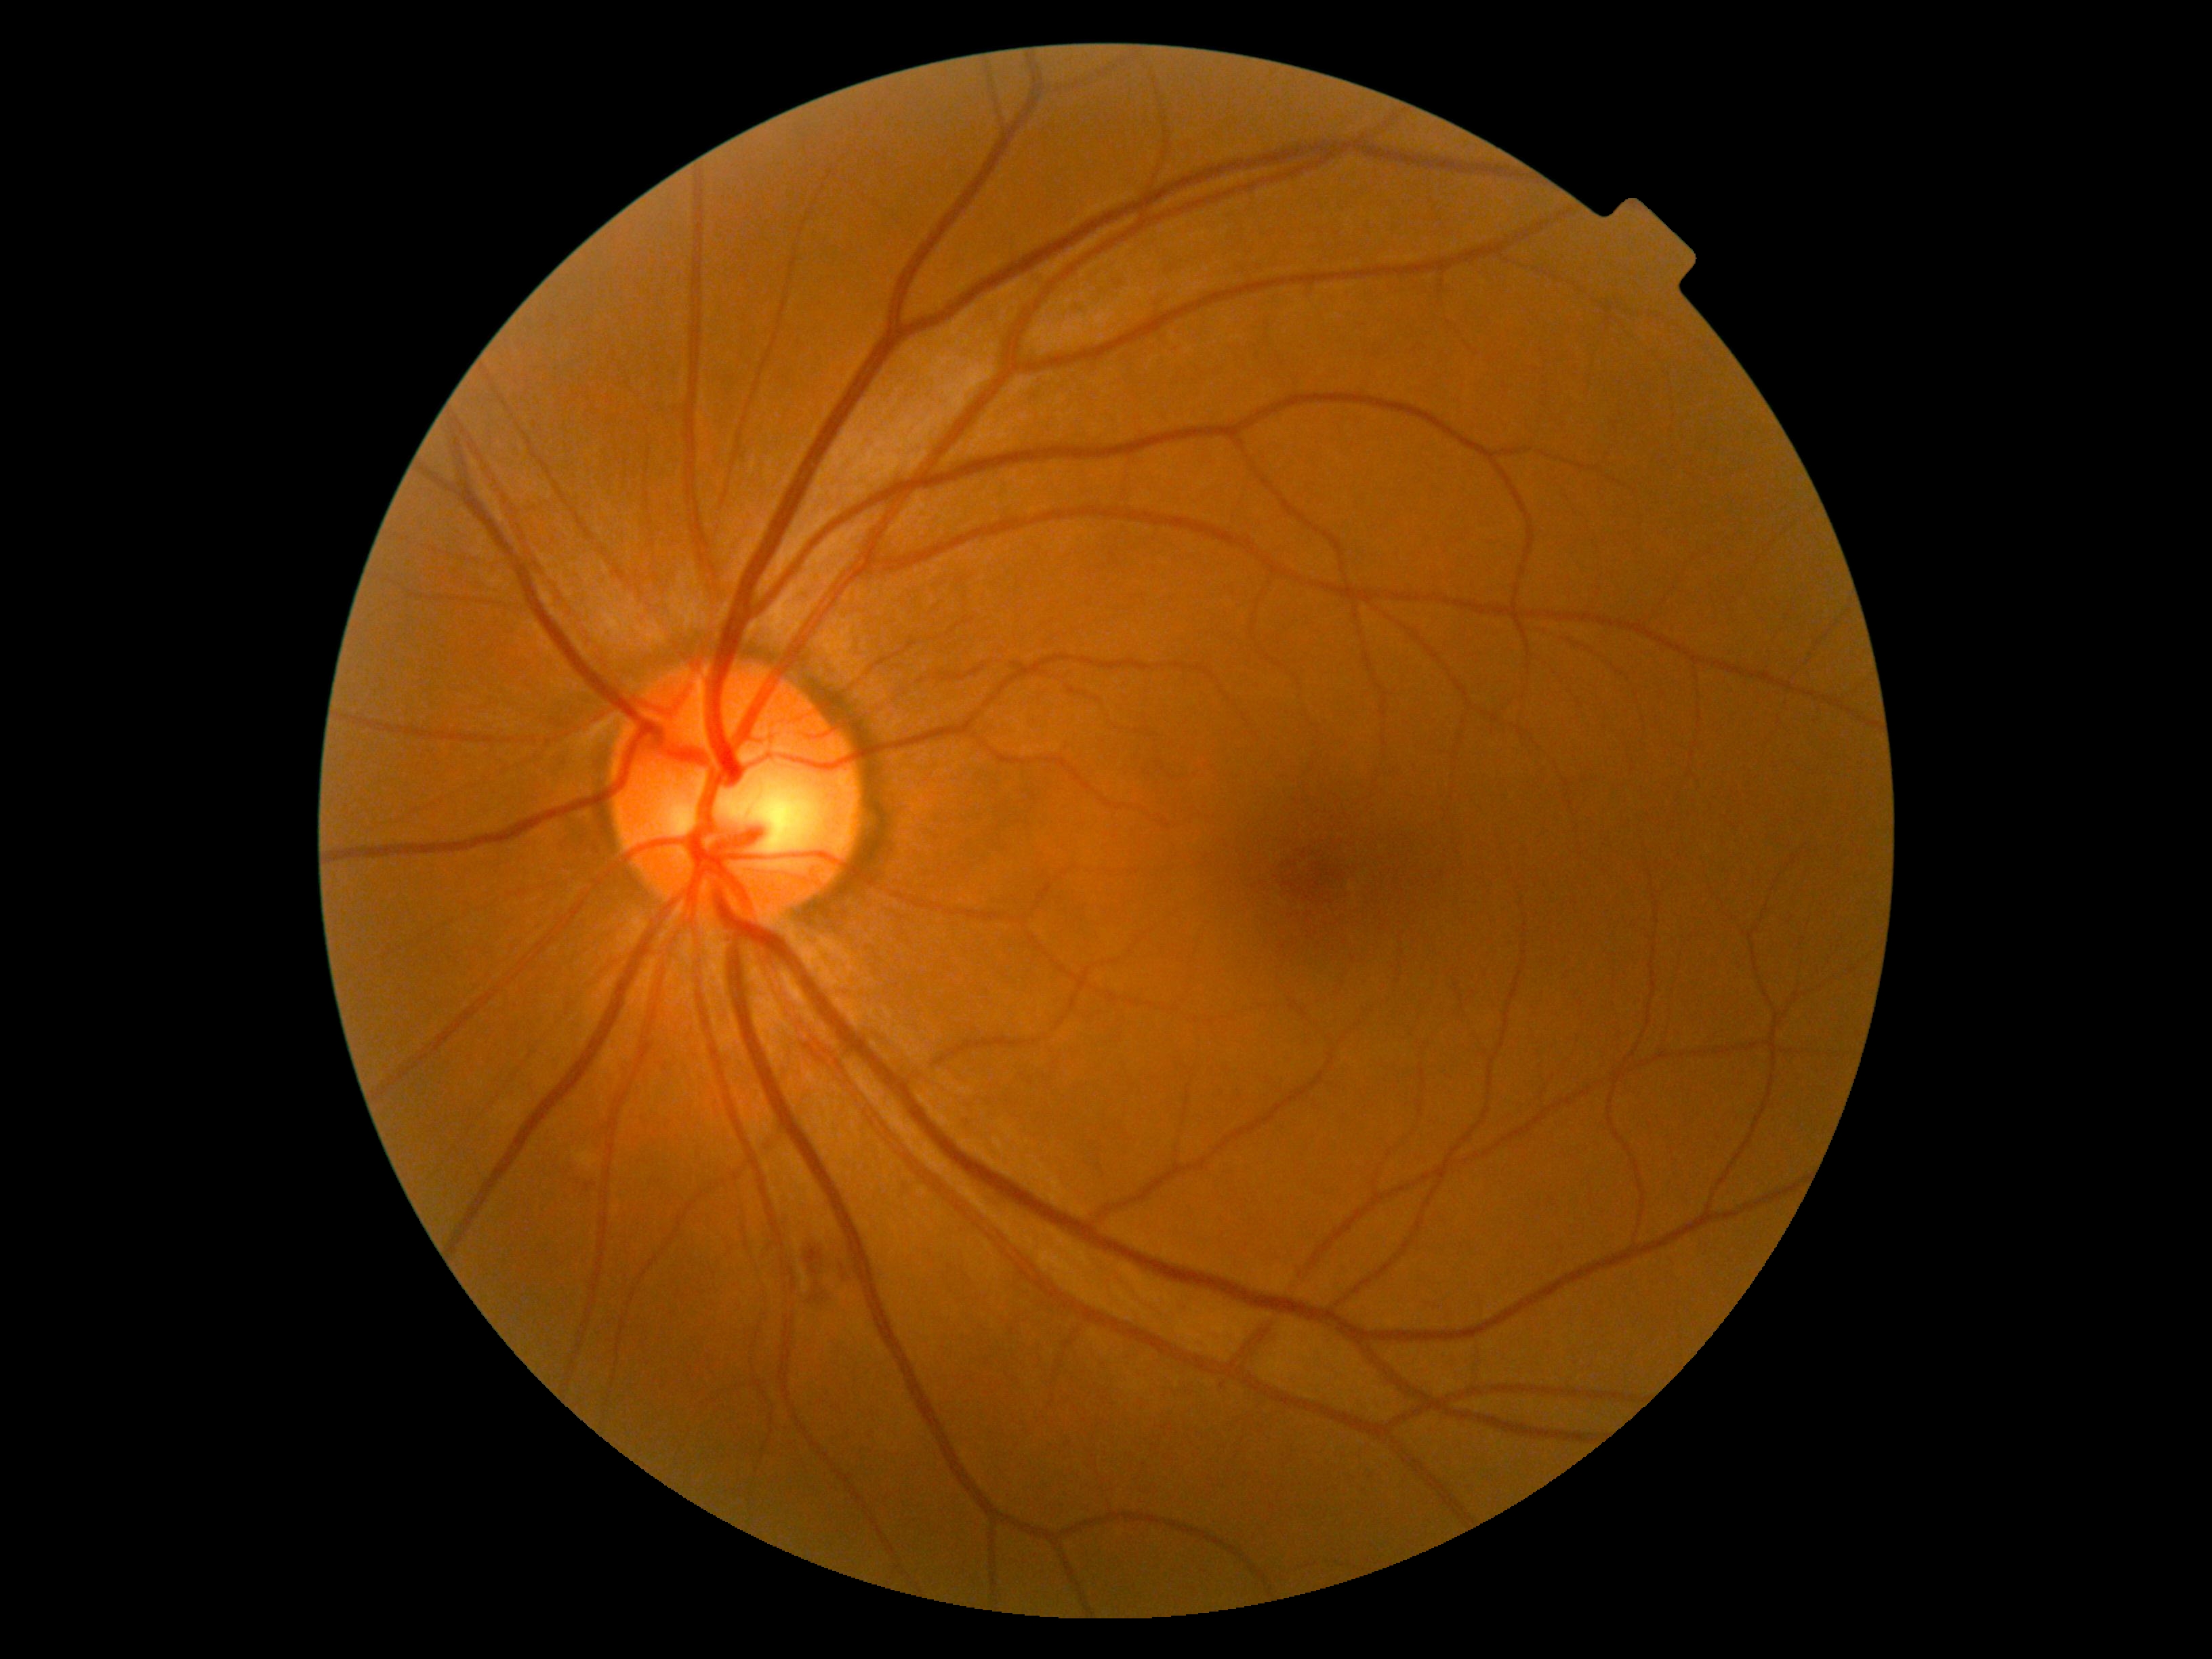

DR class: non-proliferative diabetic retinopathy. Diabetic retinopathy severity: grade 2 (moderate NPDR).